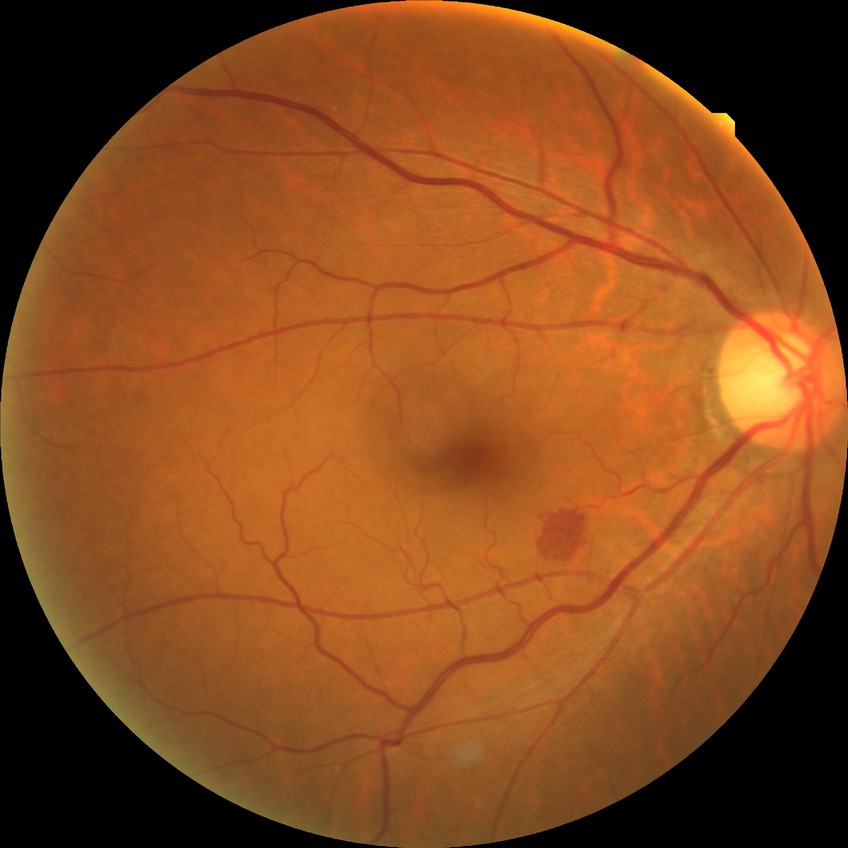
DR severity is NDR.